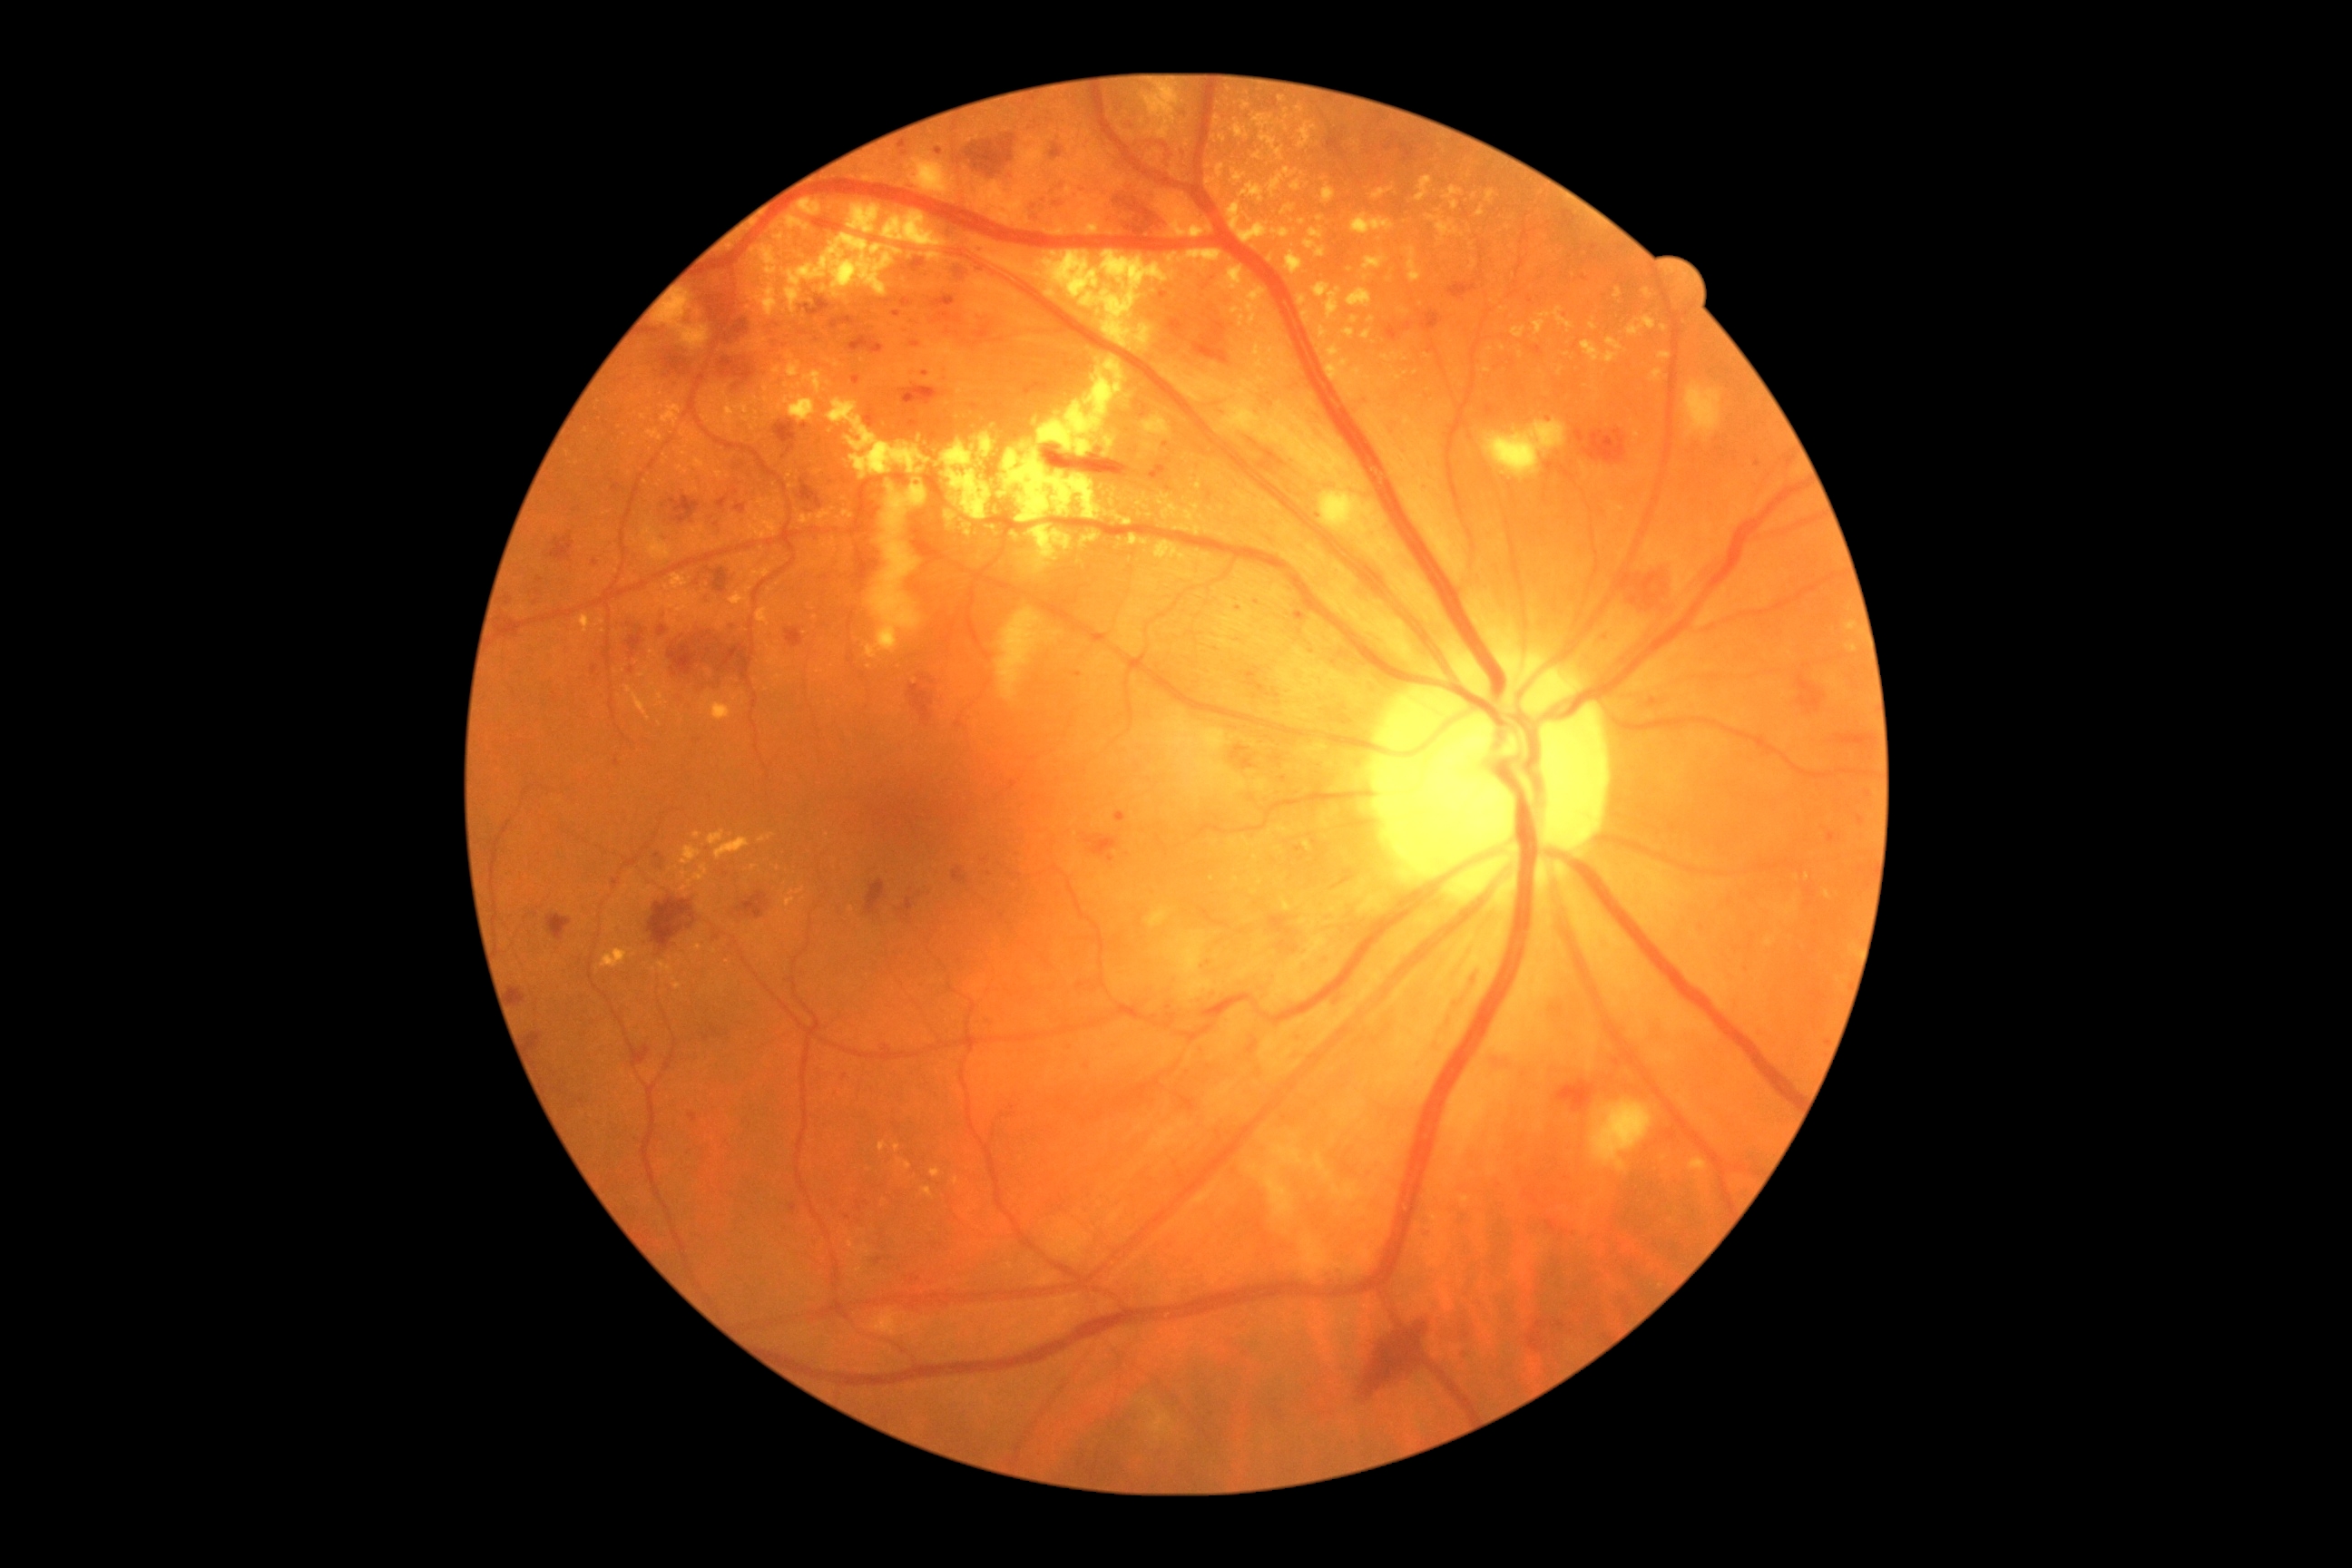
Diabetic retinopathy (DR) is 3/4. DR class: non-proliferative diabetic retinopathy.